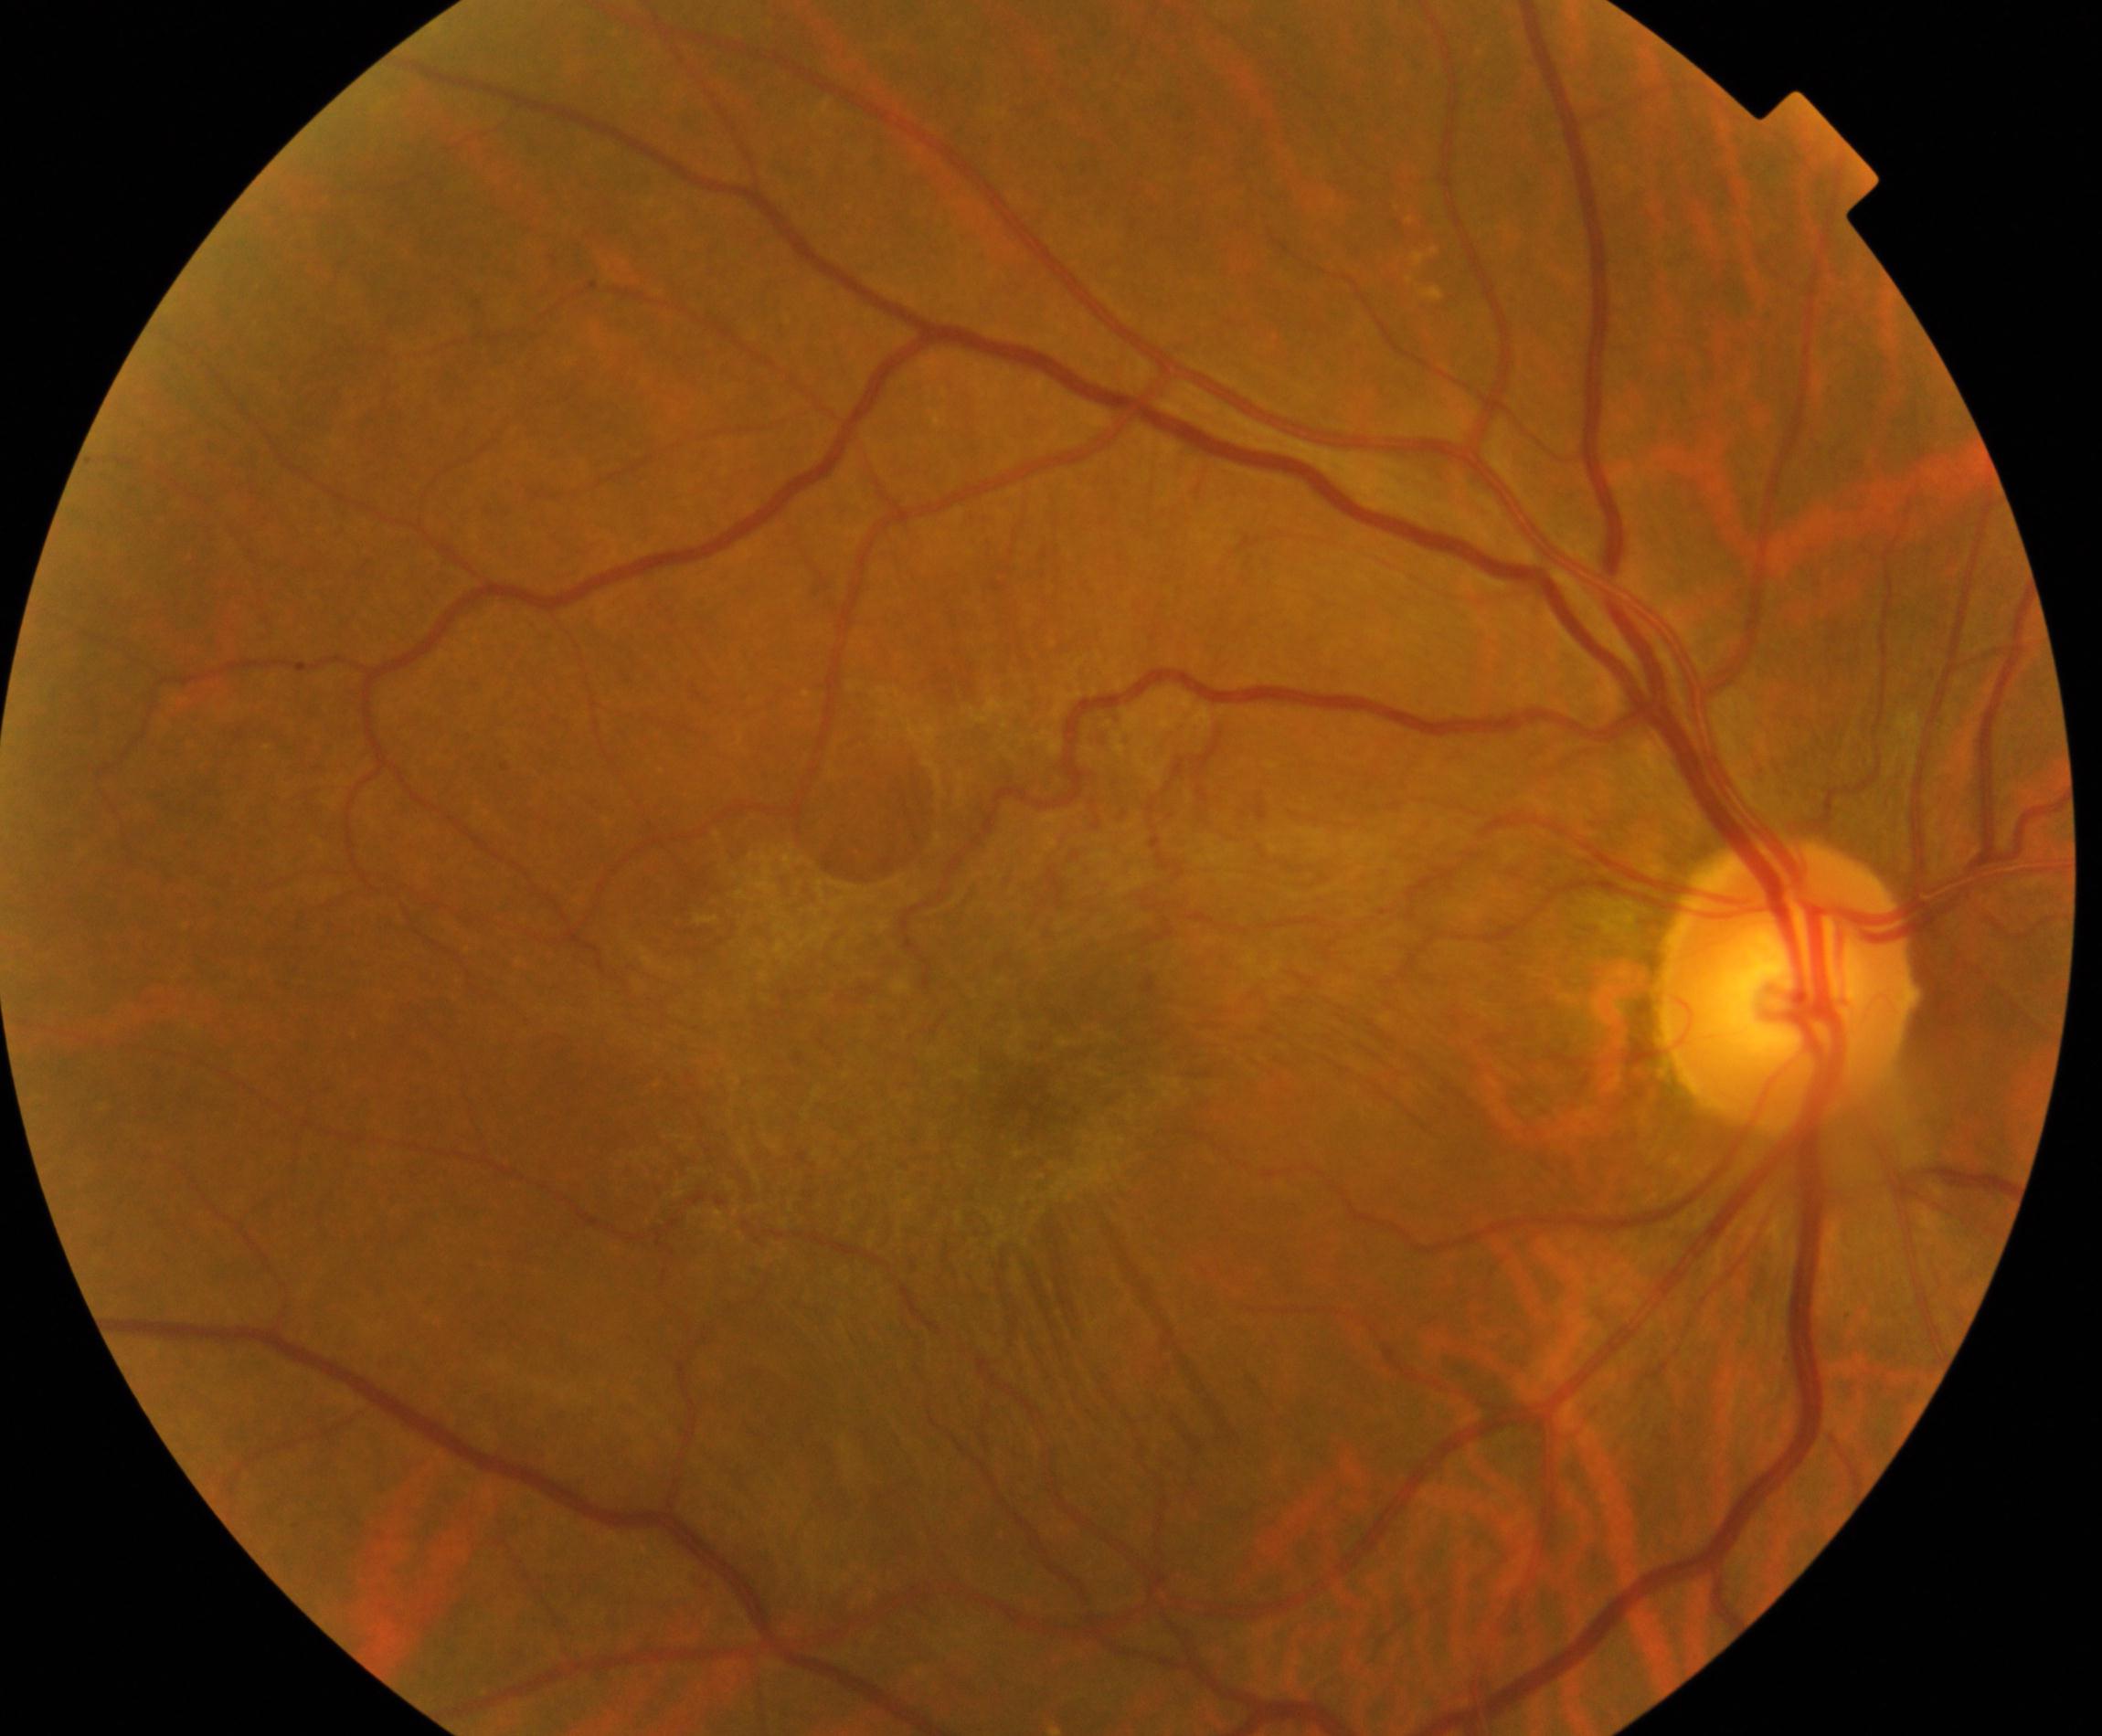

Color fundus photograph showing epiretinal membrane (ERM). Characterized by a cellophane-sheen sheet on or above the surface of the retina with macular pucker and distortion of blood vessels within the vessel arcades.